Fundus photo · 45-degree field of view · without pupil dilation · 848x848px · NIDEK AFC-230 fundus camera
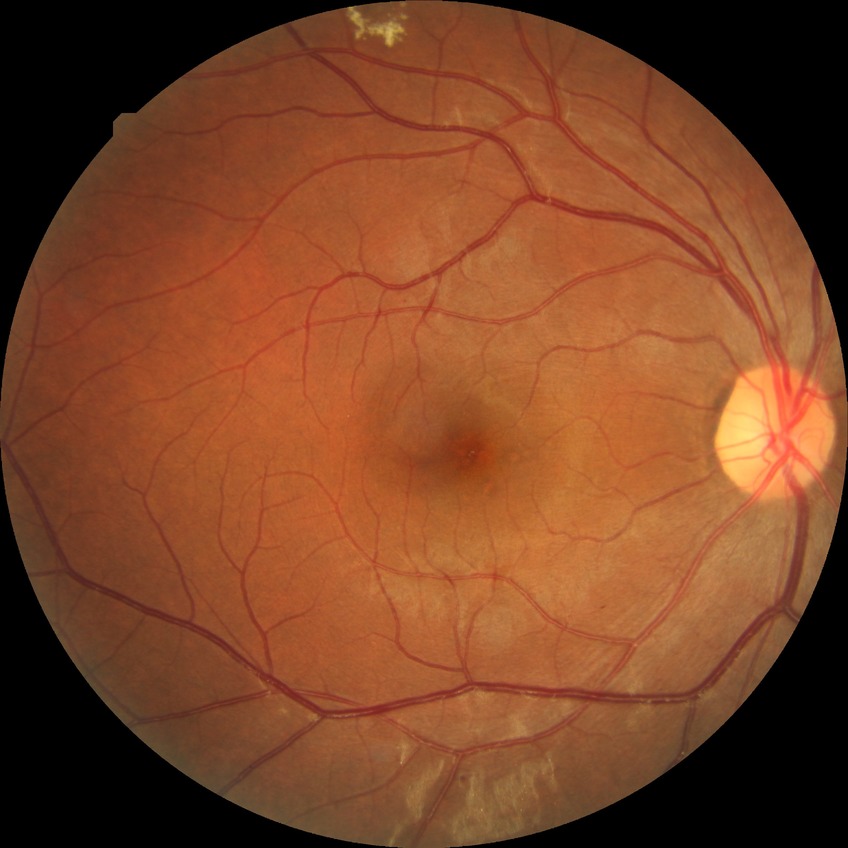

modified Davis classification = simple diabetic retinopathy.